Color fundus photograph: 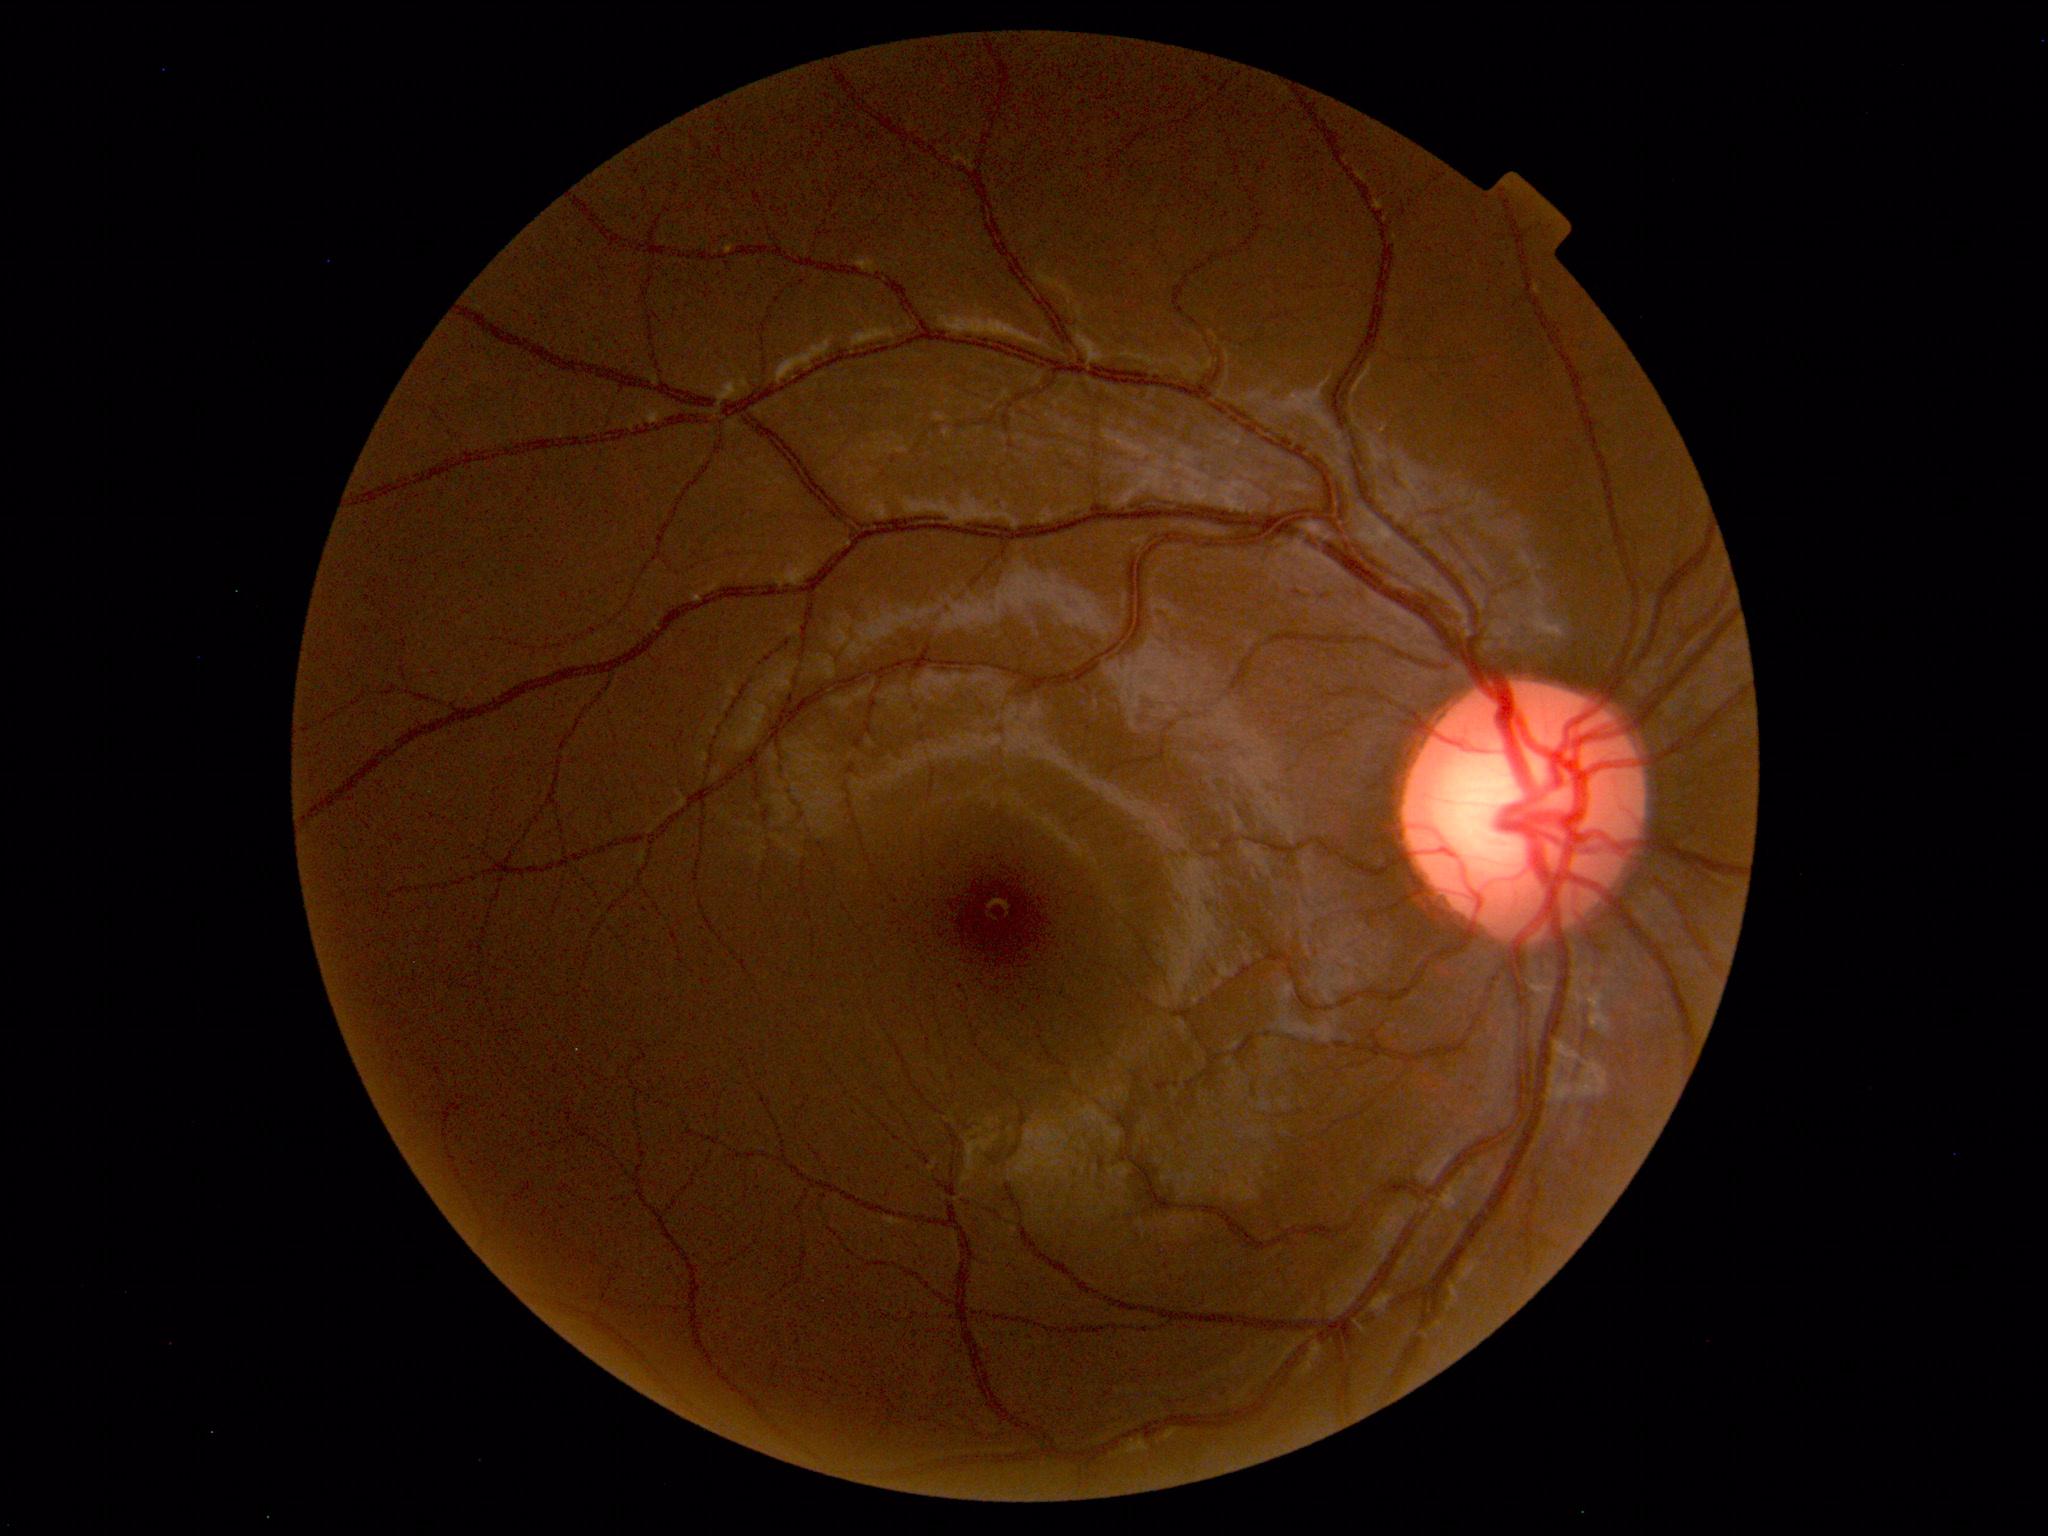

No abnormal findings on fundus examination.